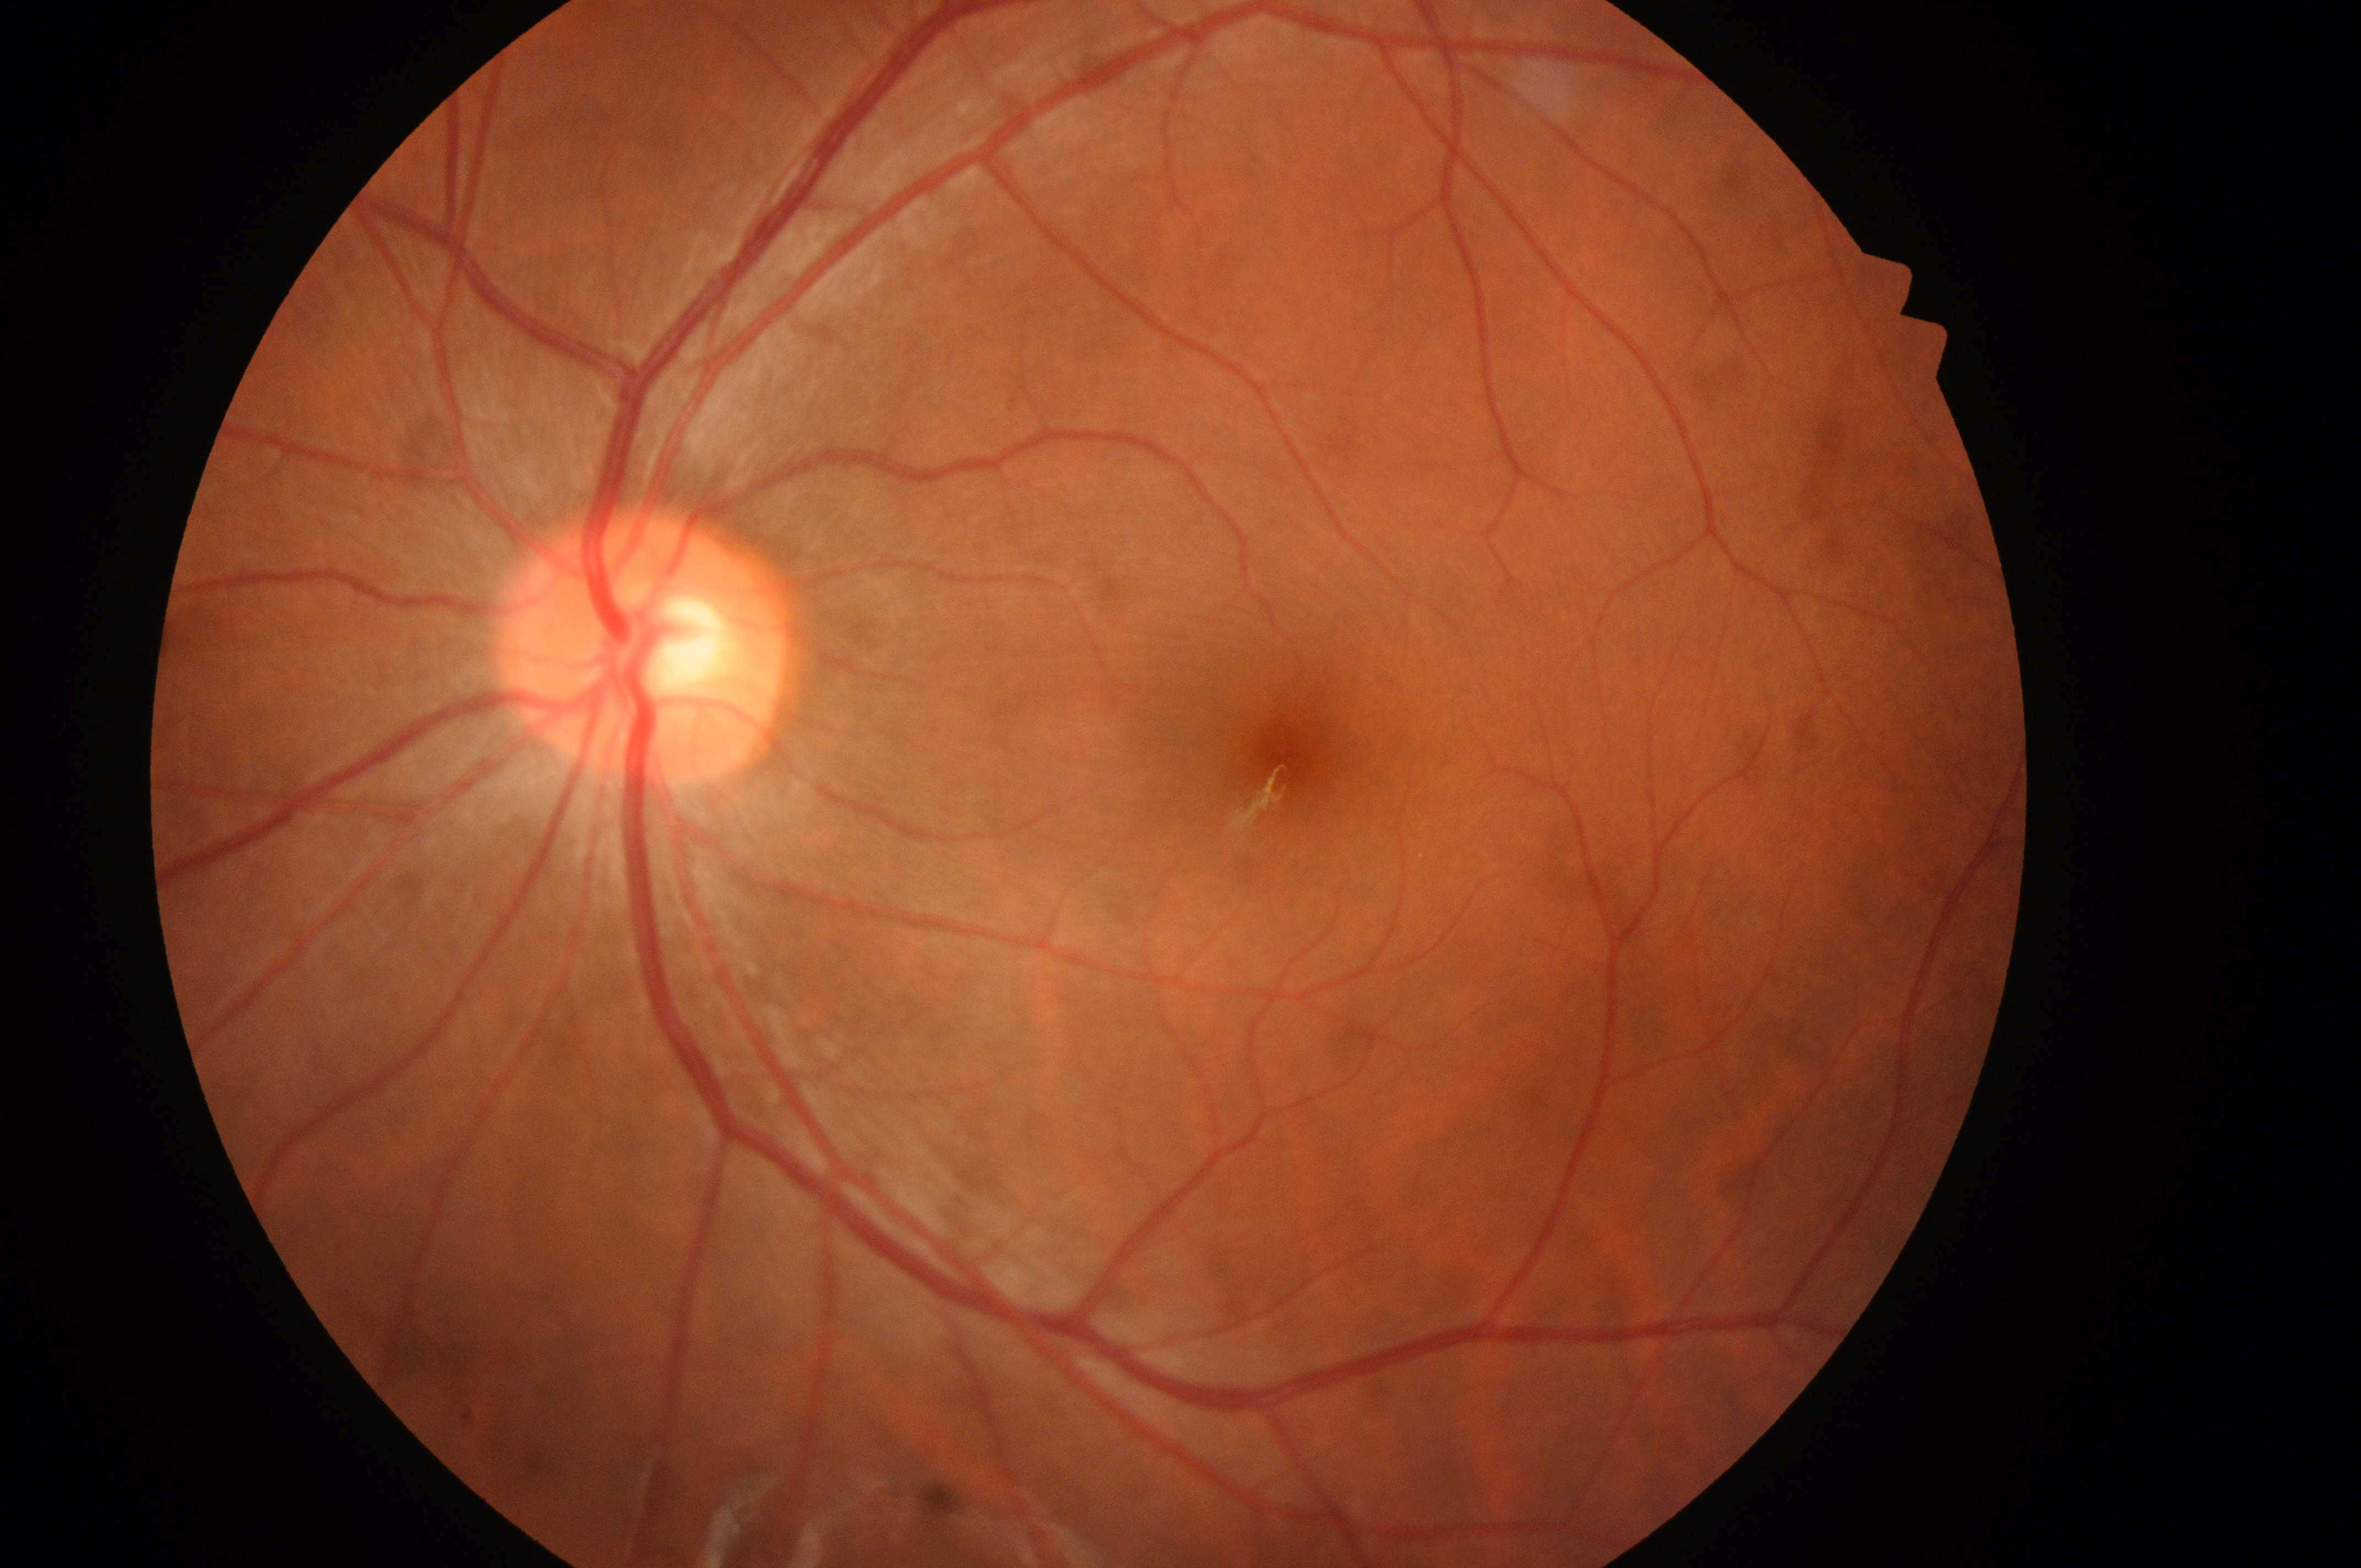

No diabetic retinal disease findings.
DME risk: 0.
Optic disk: 635, 654.
DR is 0.
The image shows the left eye.
Fovea: 1281, 763.